Fundus photo taken with a portable handheld camera:
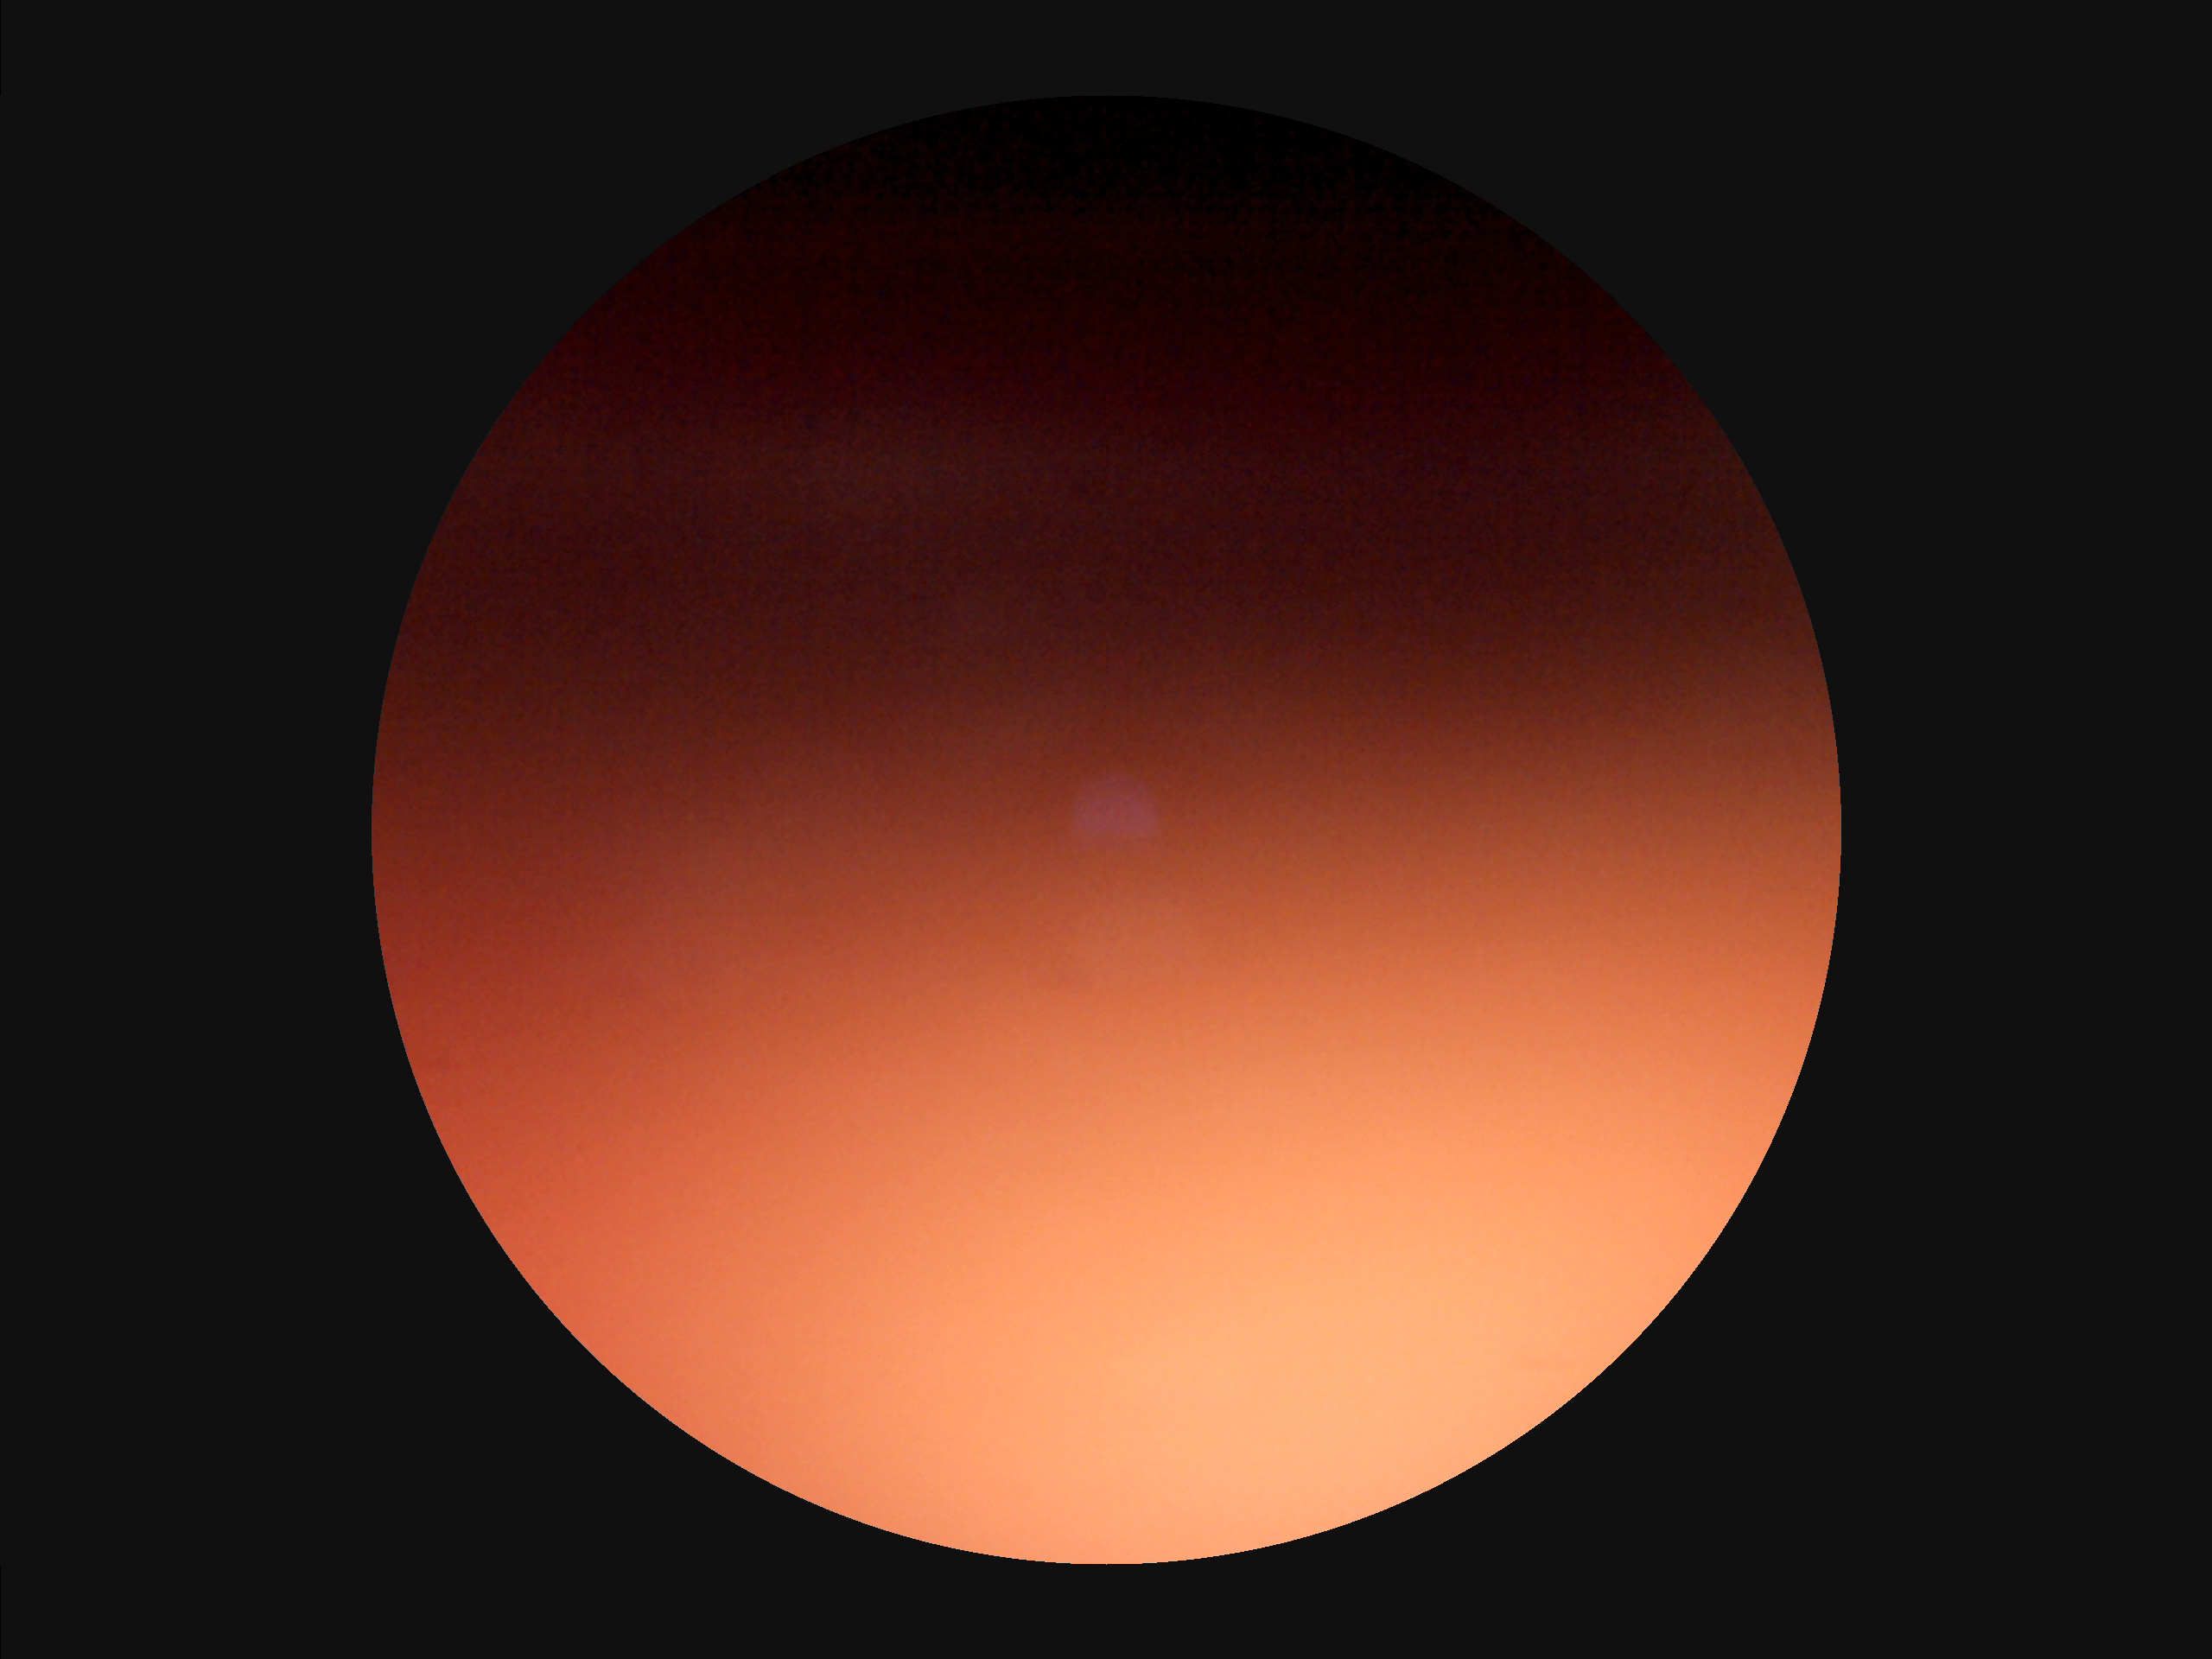

Quality grading:
- sharpness: reduced
- illumination/color: uneven
- overall: poor
- contrast: reduced